DR severity per modified Davis staging · no pharmacologic dilation
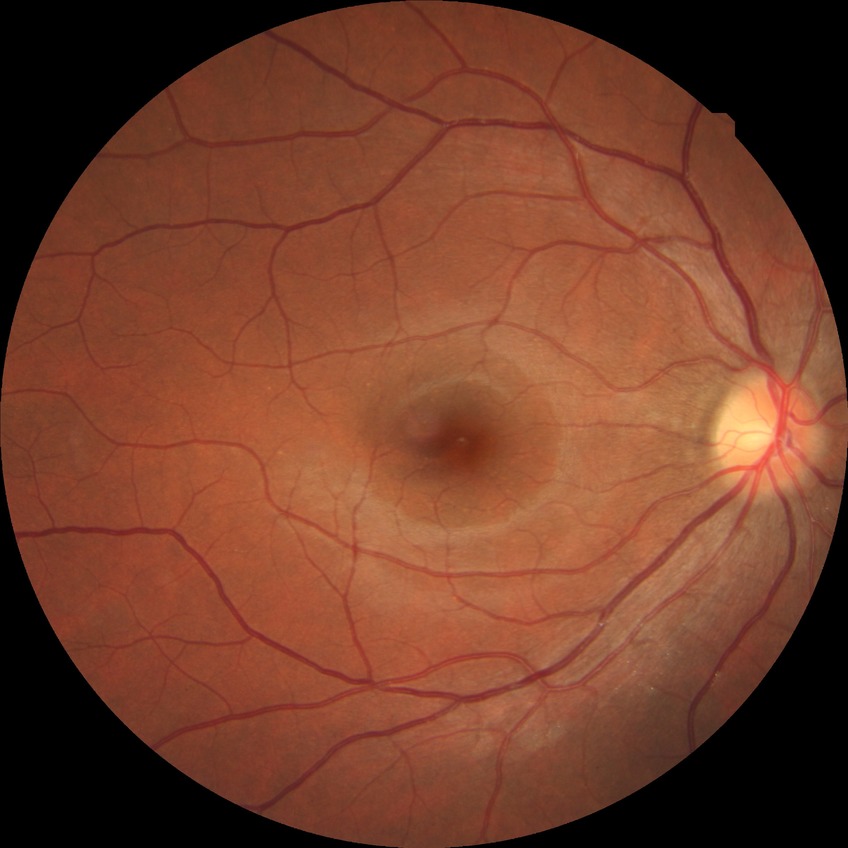
diabetic retinopathy (DR): no diabetic retinopathy (NDR)